Infant wide-field fundus photograph: 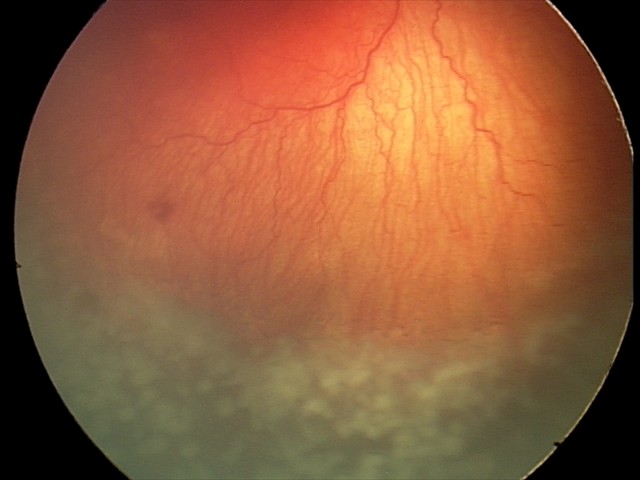
Plus form = present | screening diagnosis = aggressive retinopathy of prematurity (A-ROP).